Infant wide-field retinal image. 1440 by 1080 pixels. Camera: Natus RetCam Envision (130° FOV): 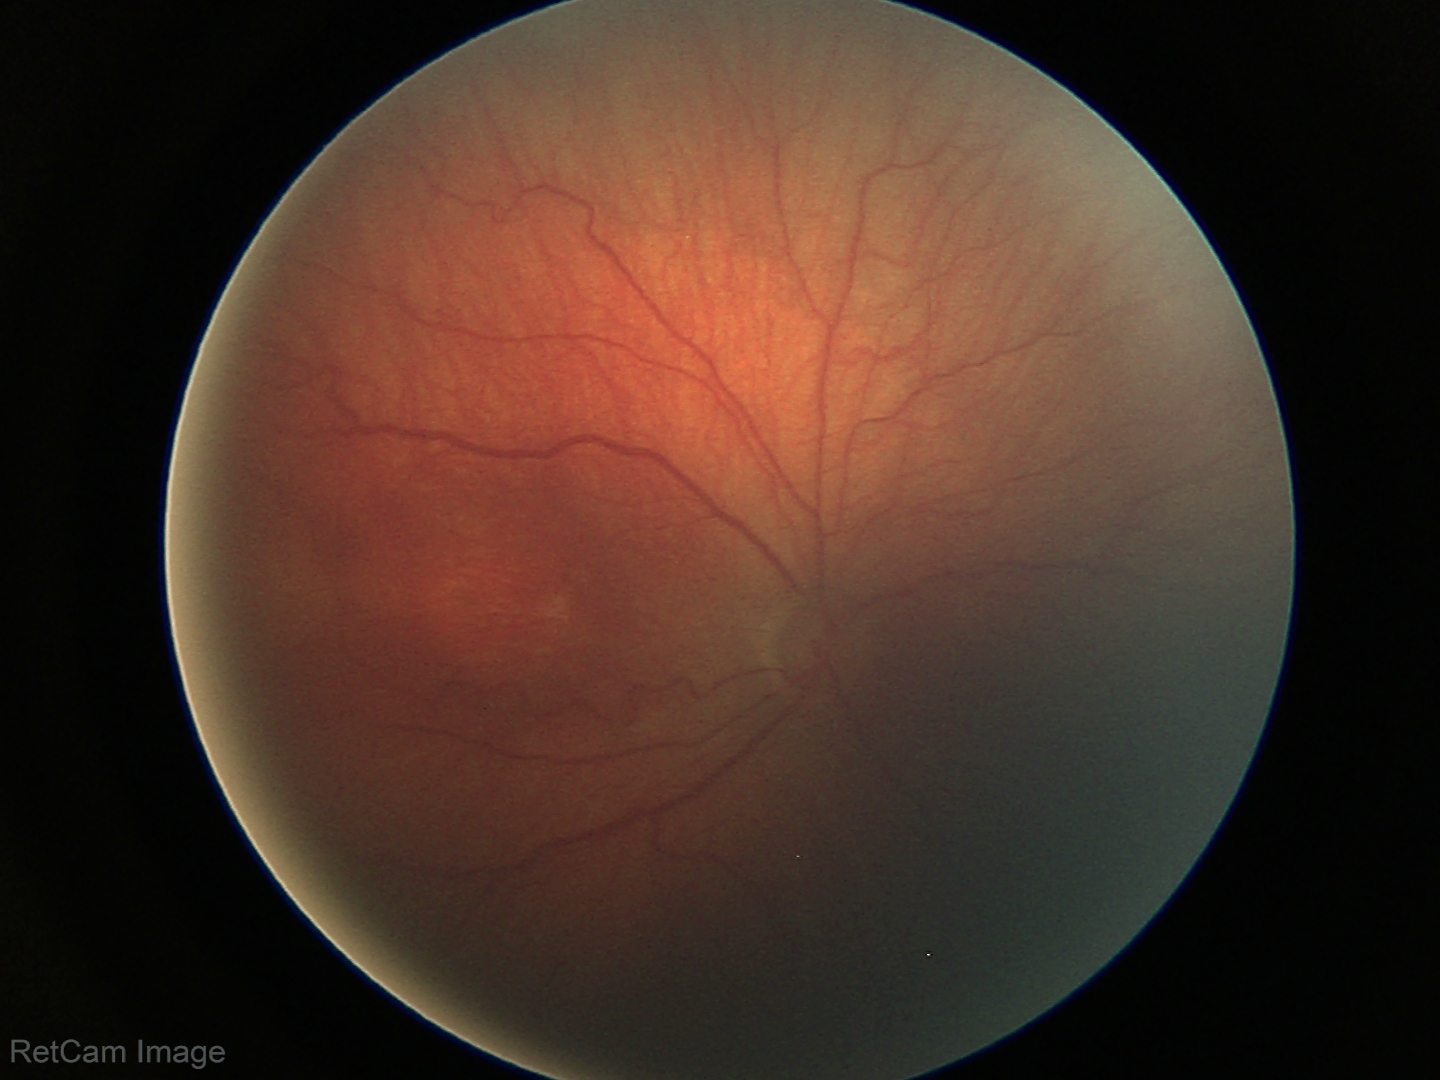
From an examination with diagnosis of retinopathy of prematurity (ROP) stage 3 — ridge with extraretinal fibrovascular proliferation.
Plus disease absent.